Fundus photo — 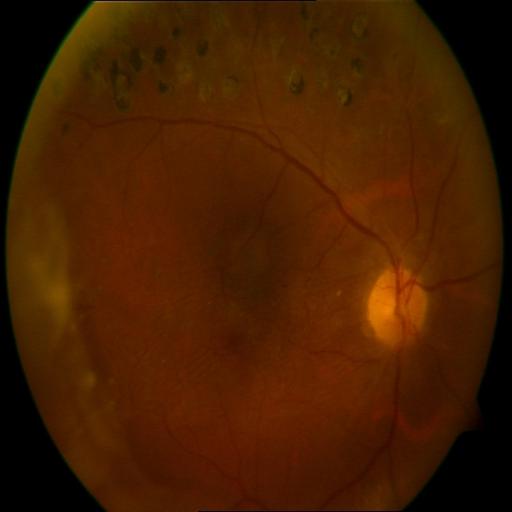

Showing laser scars (LS).